Retinal fundus photograph:
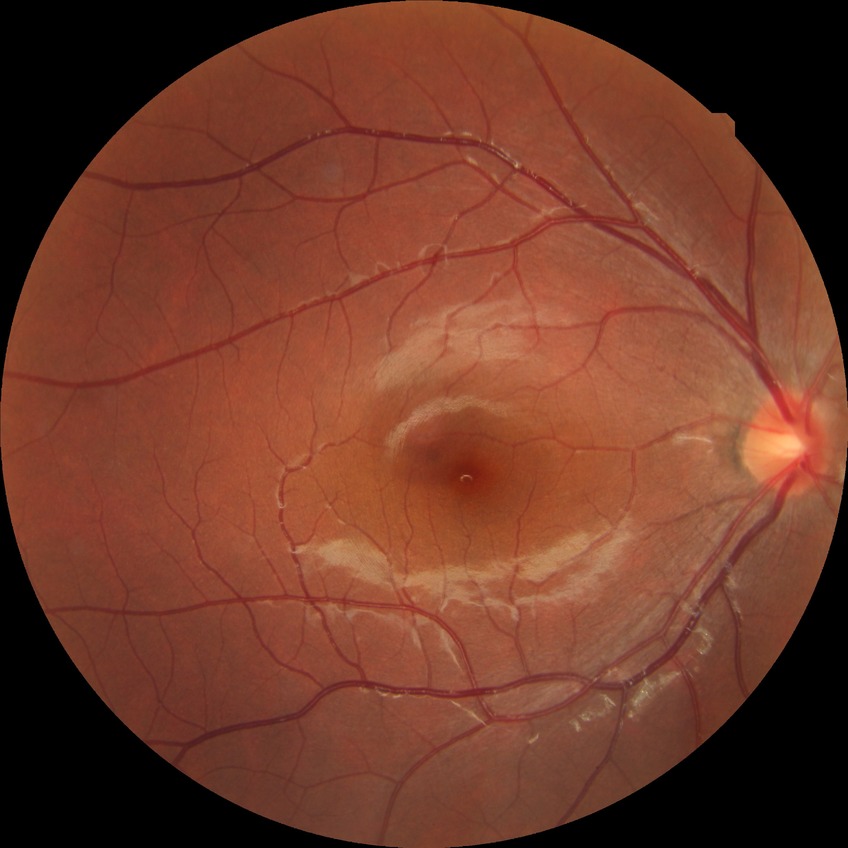
Assessment:
– diabetic retinopathy (DR): no diabetic retinopathy (NDR)